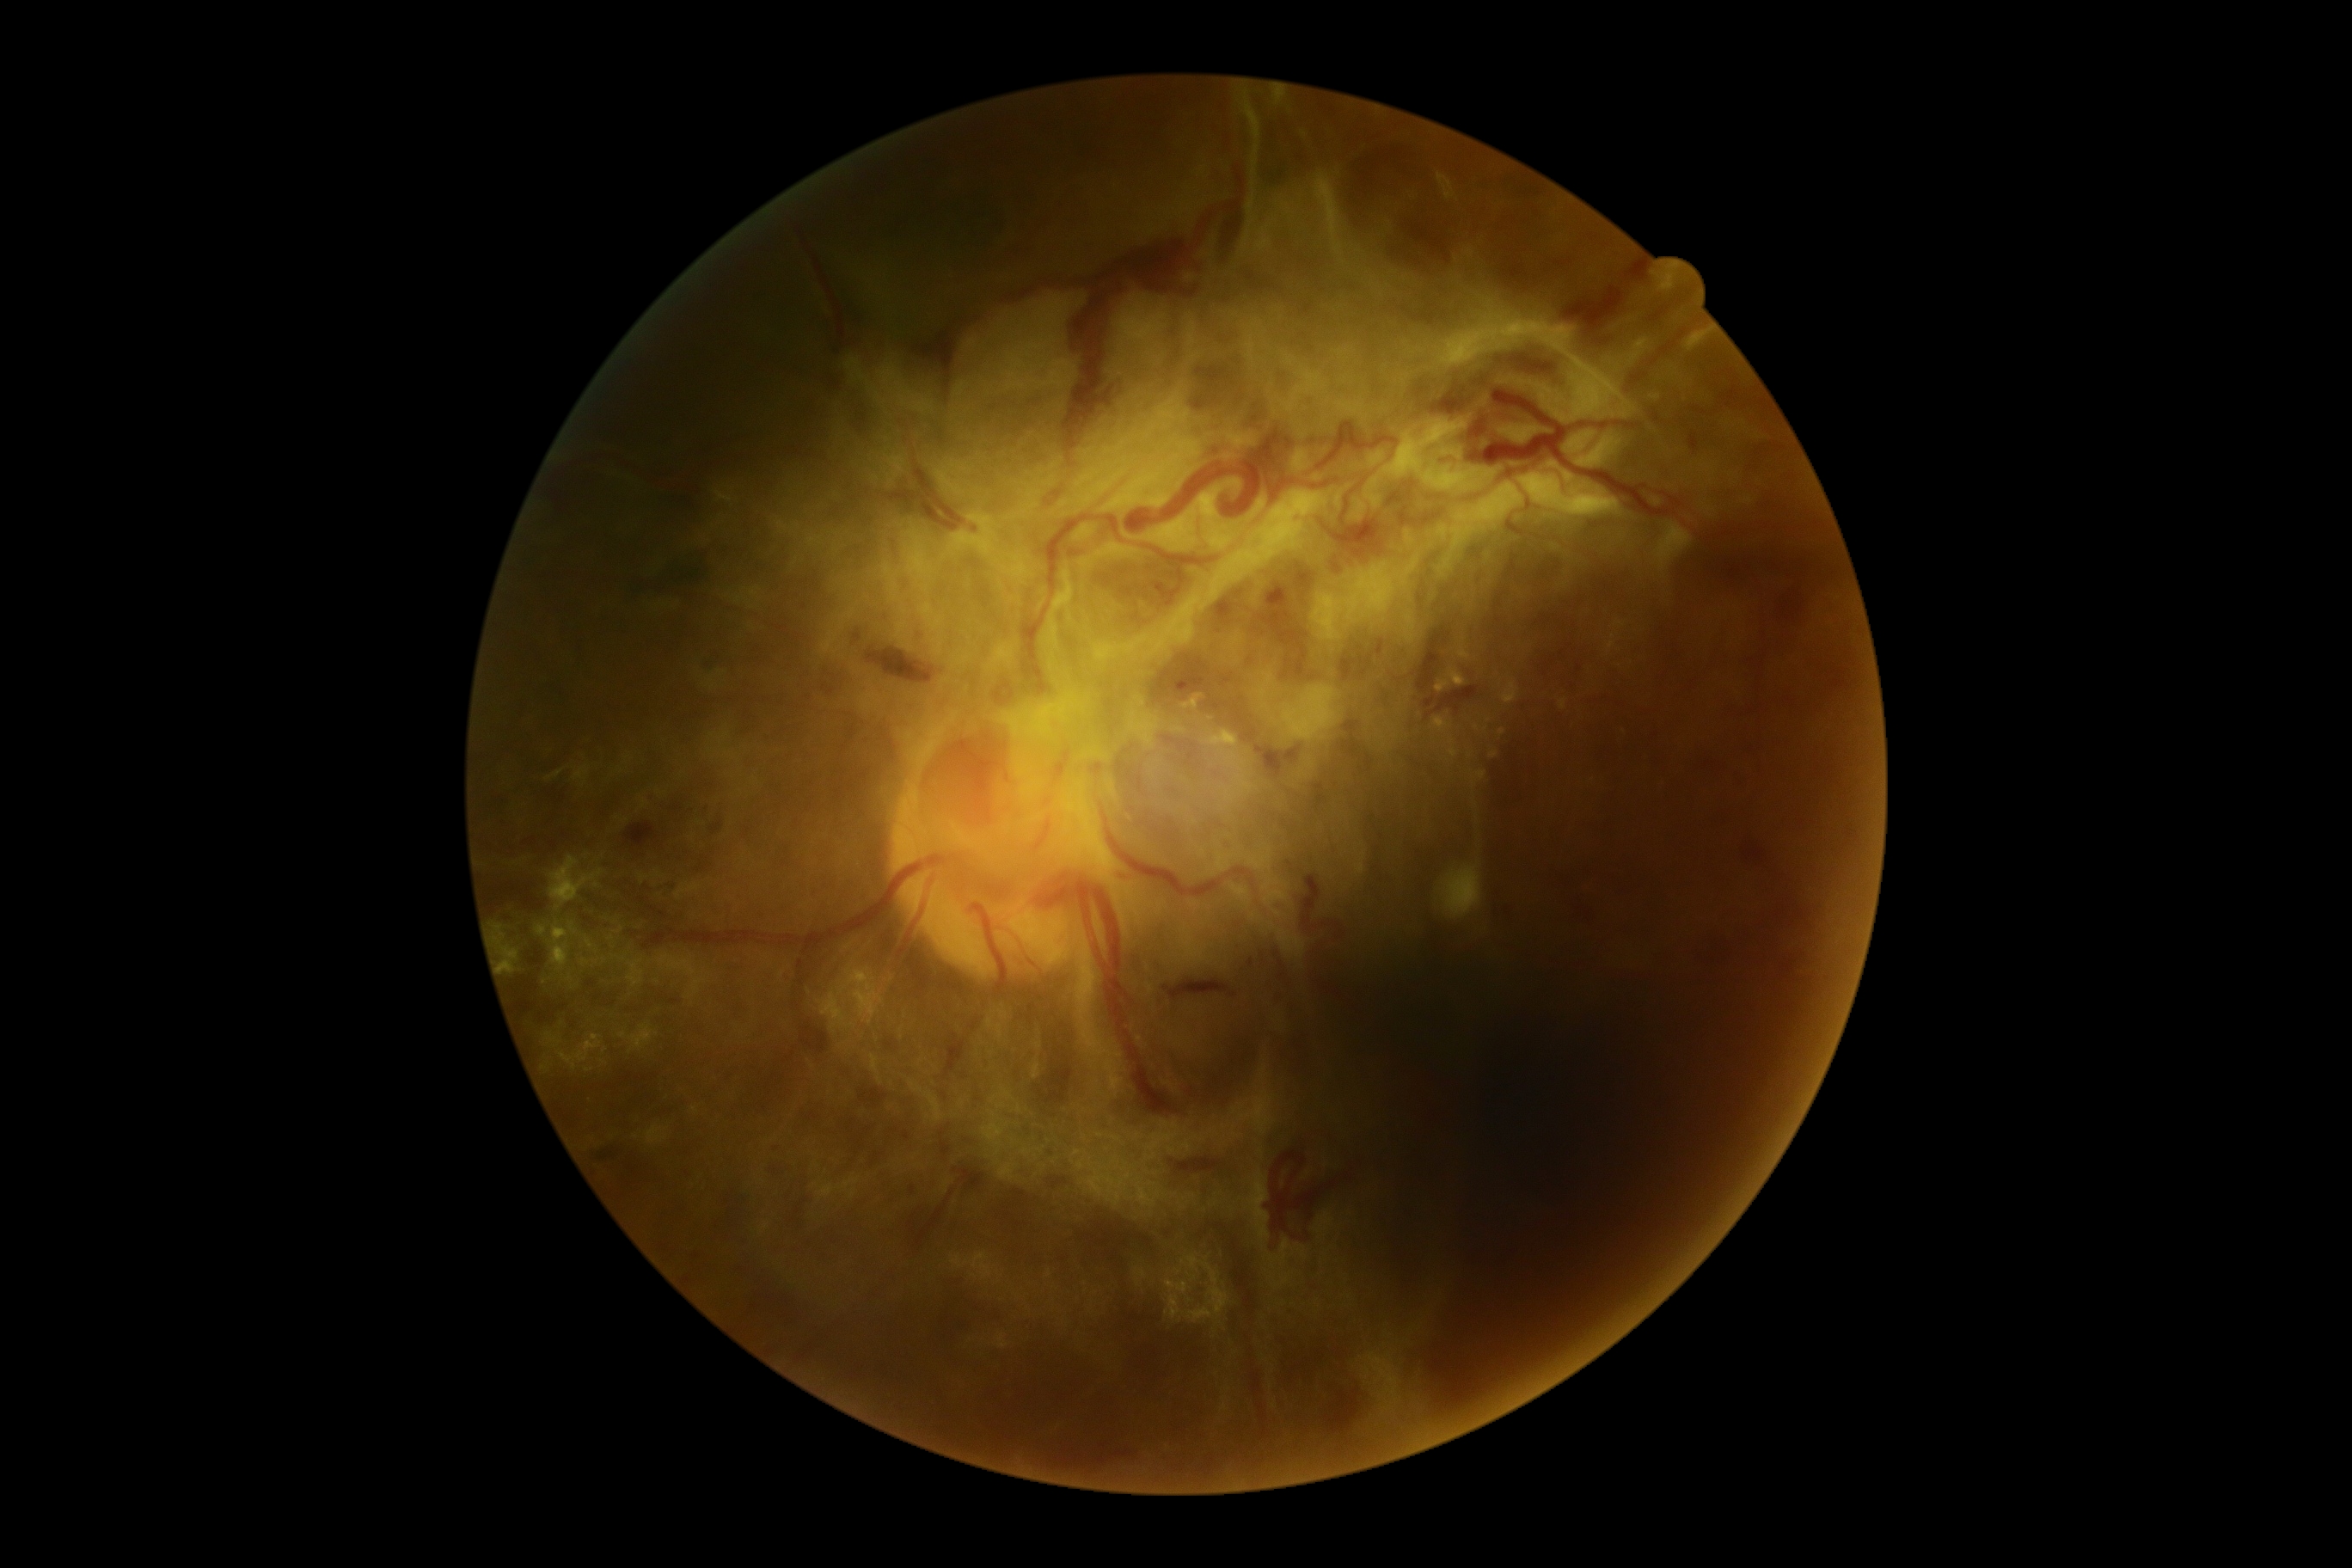
DR grade: 4 (PDR).